CFP; 2352x1568; FOV: 45 degrees: 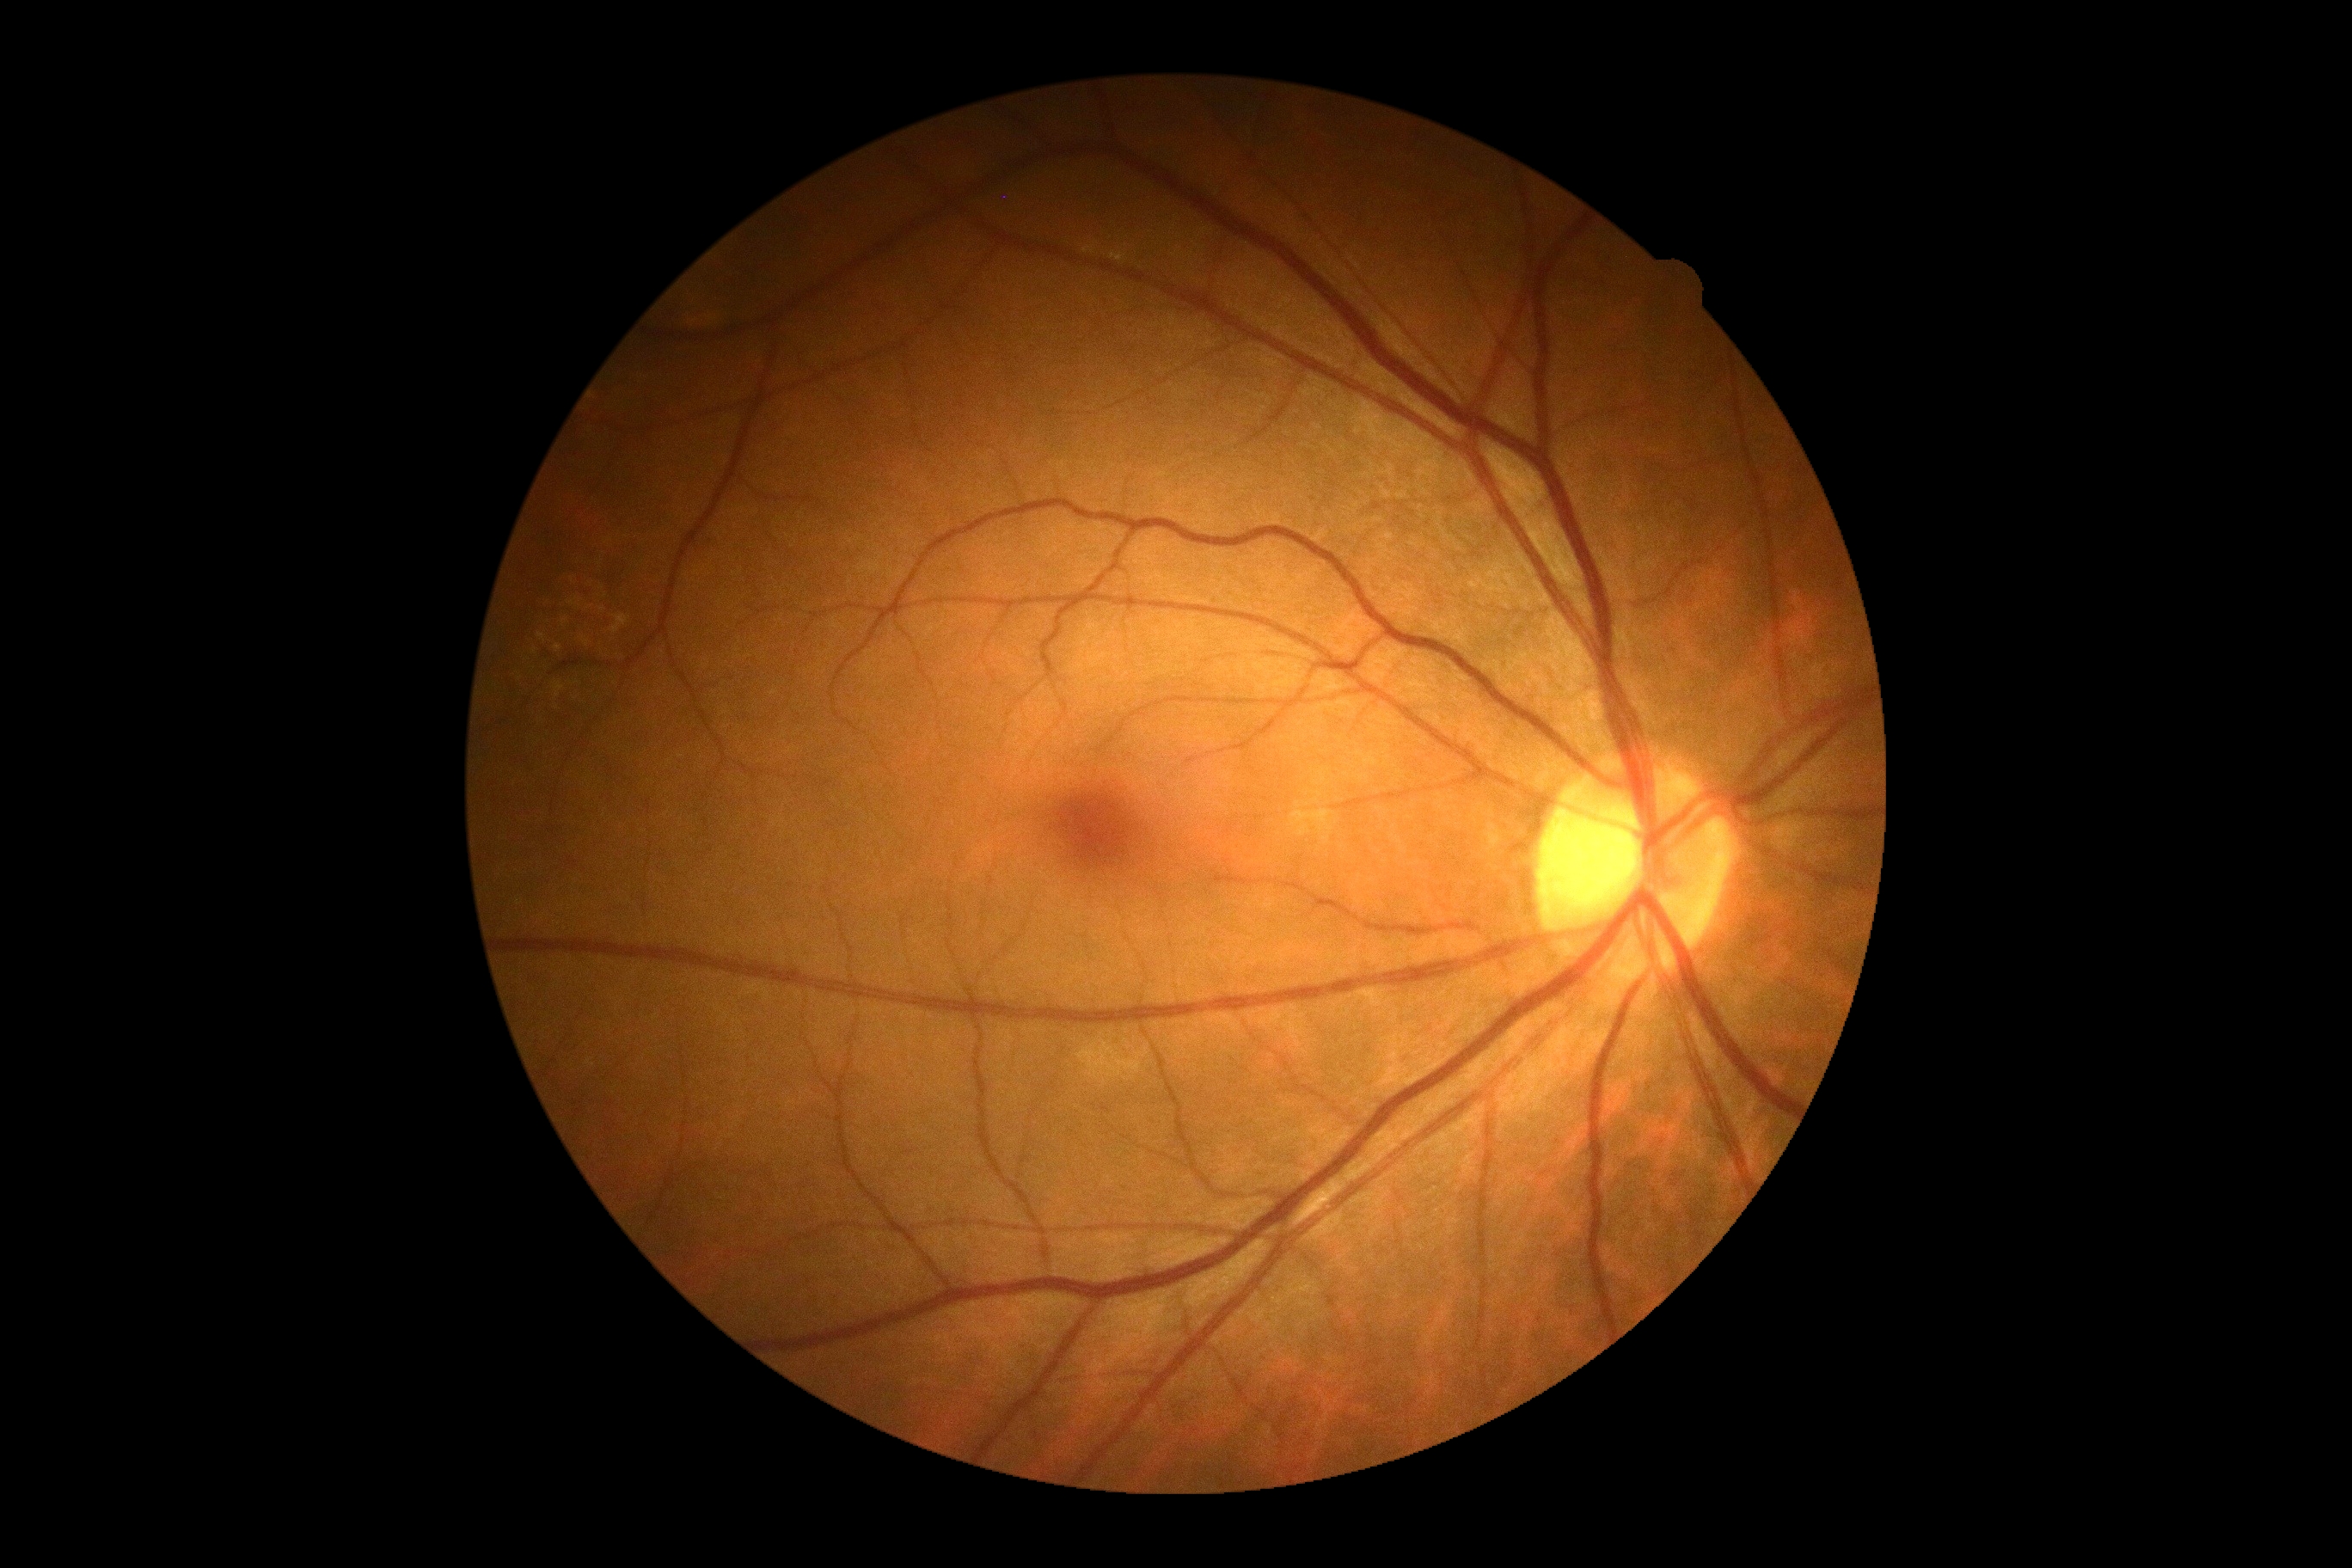
No apparent diabetic retinopathy.
DR severity: no apparent diabetic retinopathy (grade 0).